Captured on a Nidek AFC-330 fundus camera
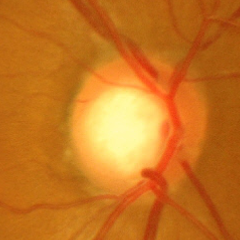

Q: What is the glaucoma diagnosis?
A: Advanced-stage glaucoma.